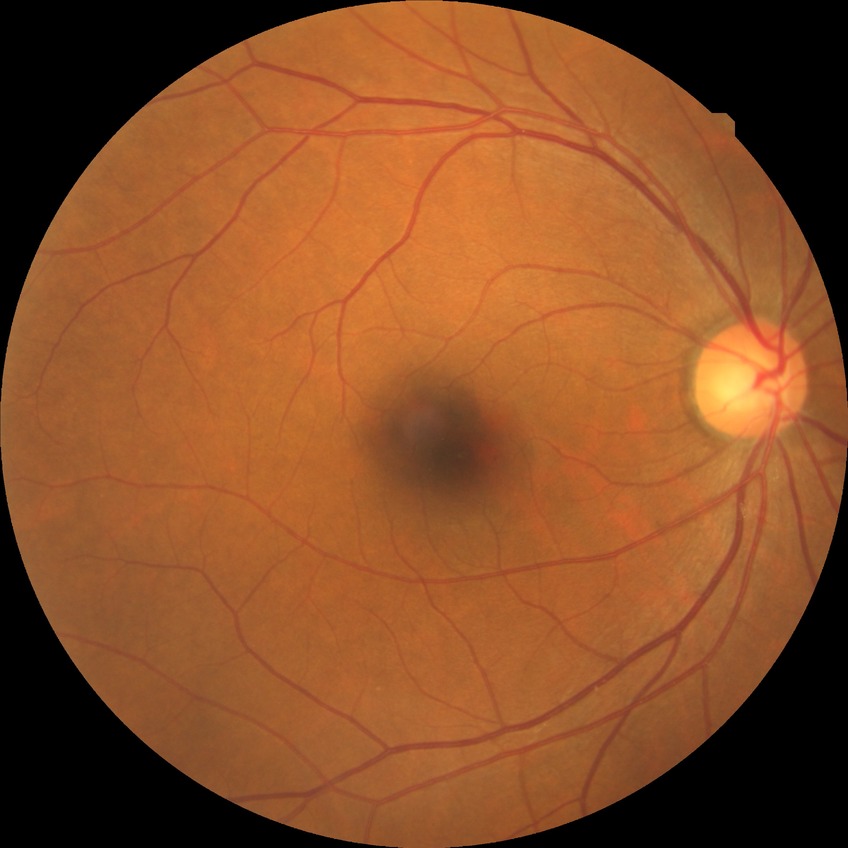

Davis grading is simple diabetic retinopathy.